50° FOV, color fundus image — 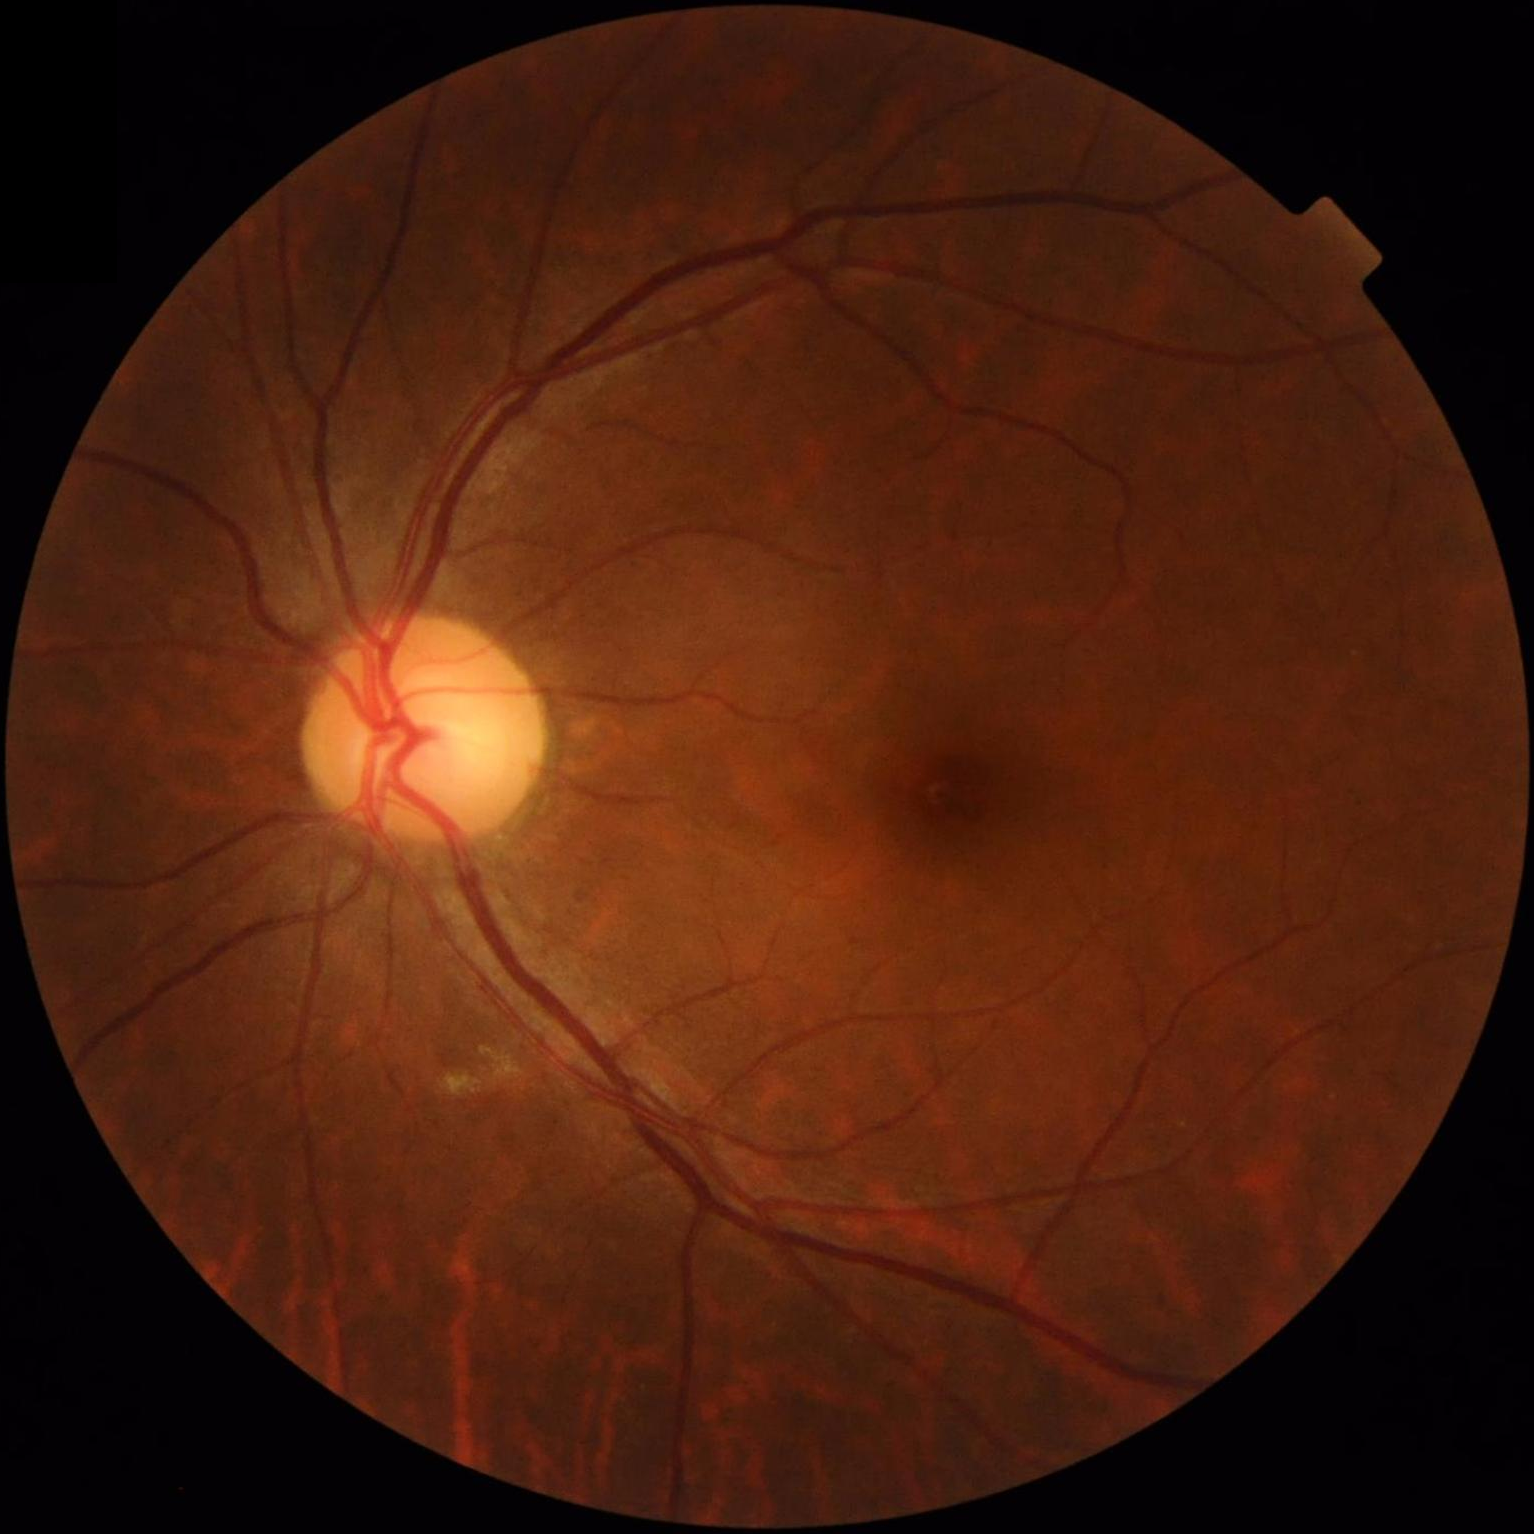

Image quality: overall: satisfactory | clarity: good | contrast: adequate.